45-degree field of view, 2352x1568.
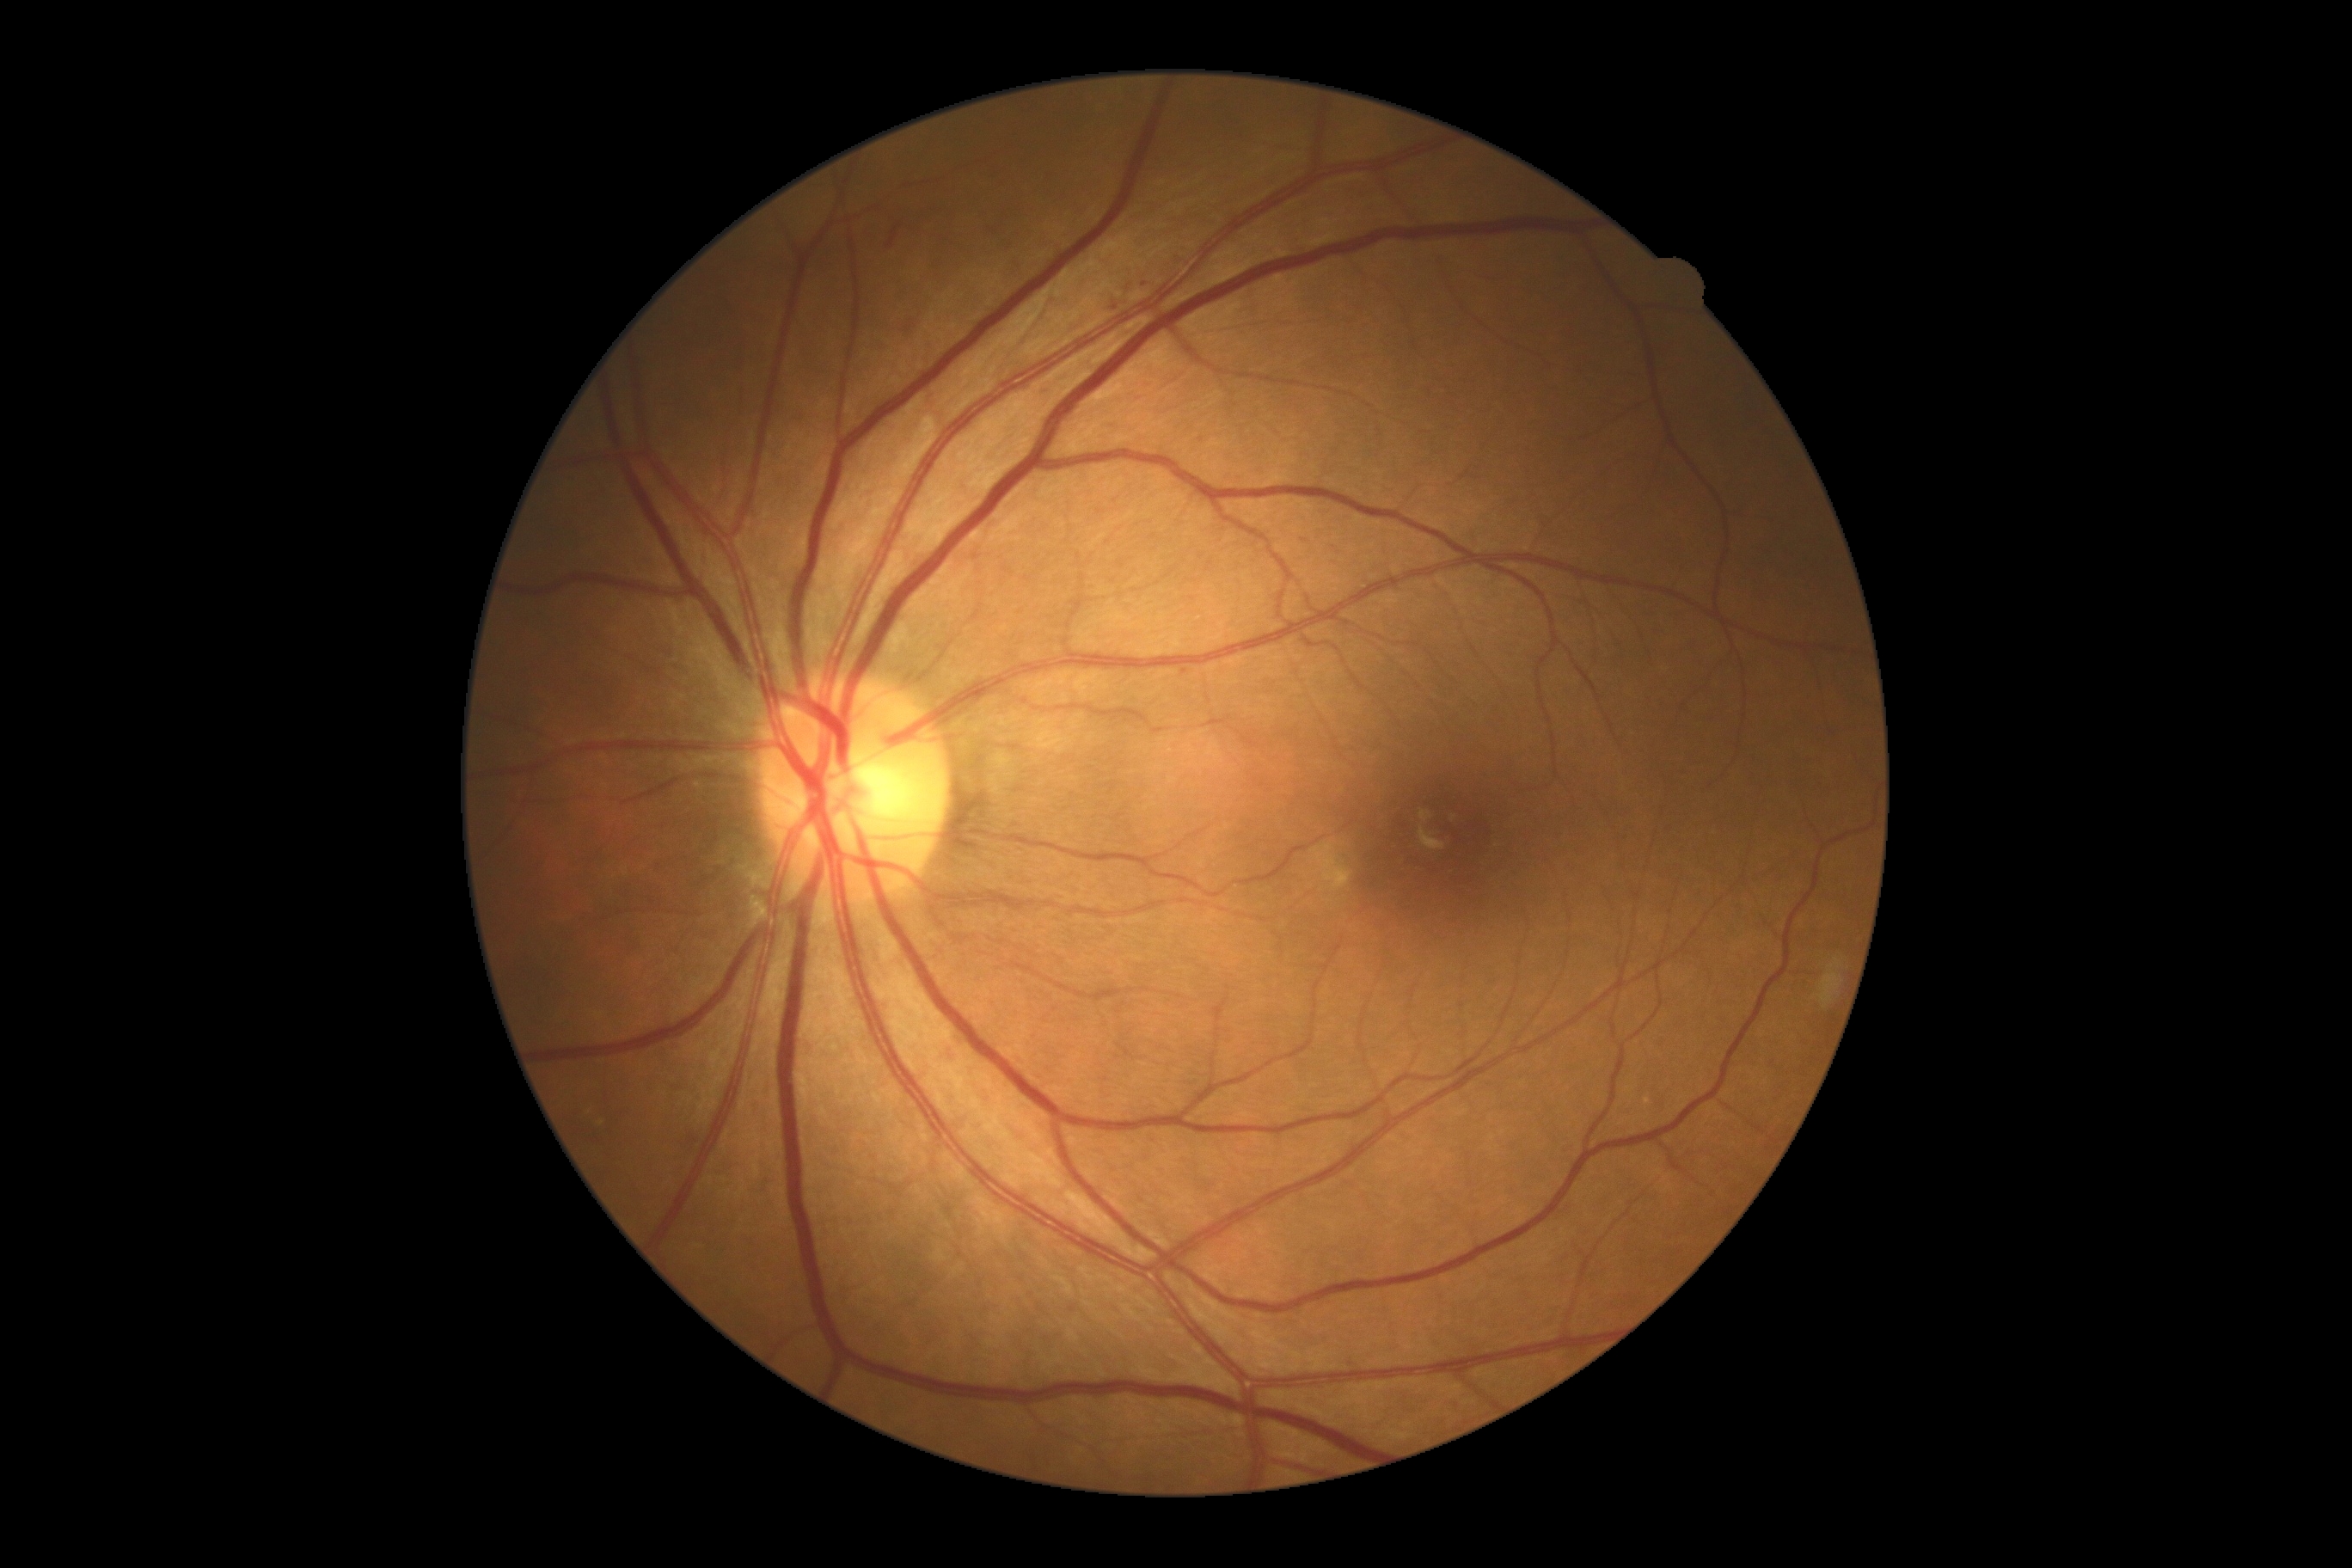 DR stage = 2/4 — more than just microaneurysms but less than severe NPDR.